Wide-field contact fundus photograph of an infant · 130° field of view (Clarity RetCam 3) · image size 640x480
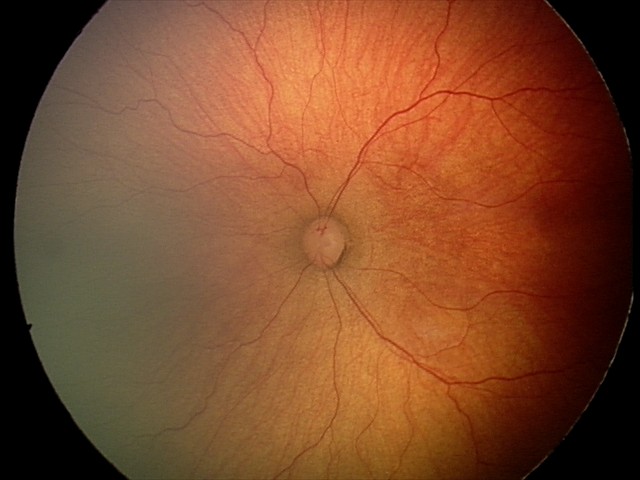

From an examination with diagnosis of retinopathy of prematurity stage 2. Without plus disease.